640 x 480 pixels · 130° field of view (Clarity RetCam 3) · wide-field fundus photograph of an infant — 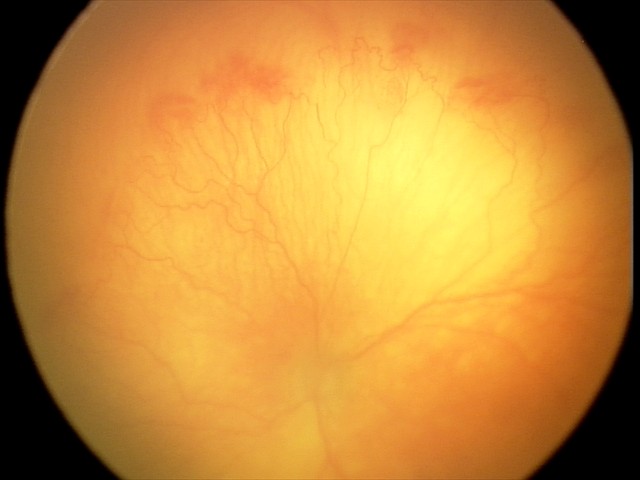 From an examination with diagnosis of aggressive retinopathy of prematurity (A-ROP). Plus disease was diagnosed.